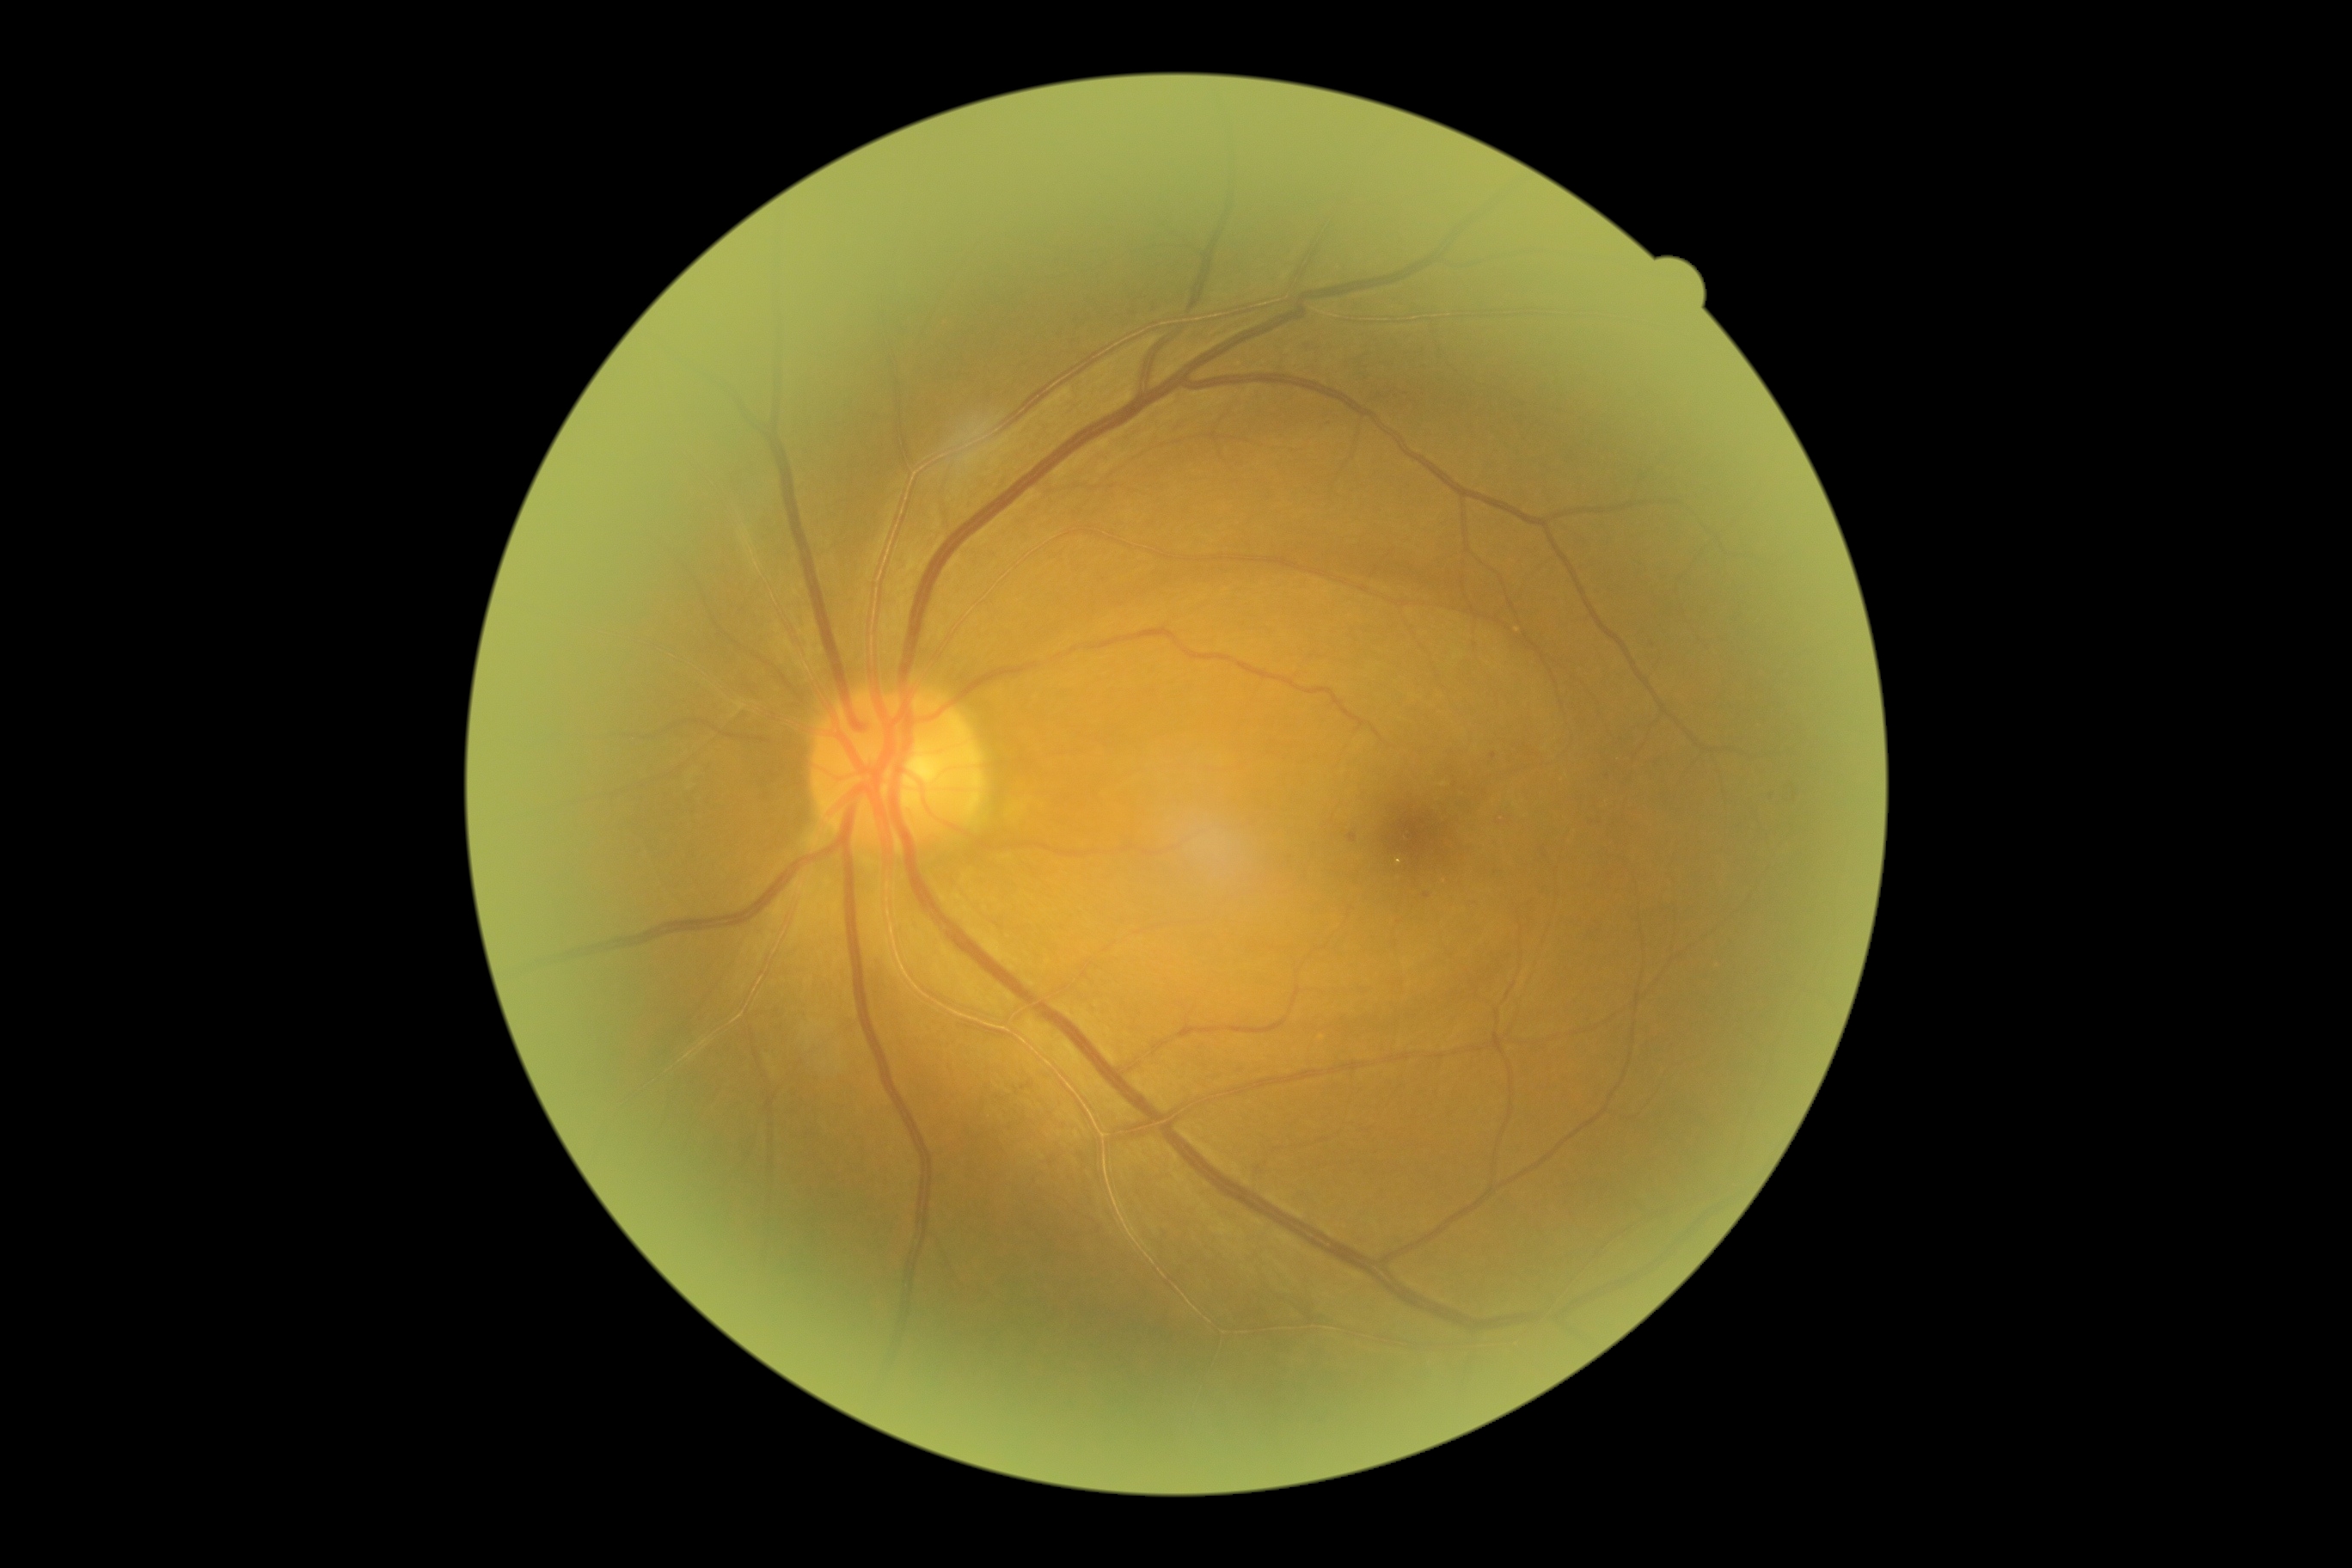

- DR grade: 1